1924x1556px: 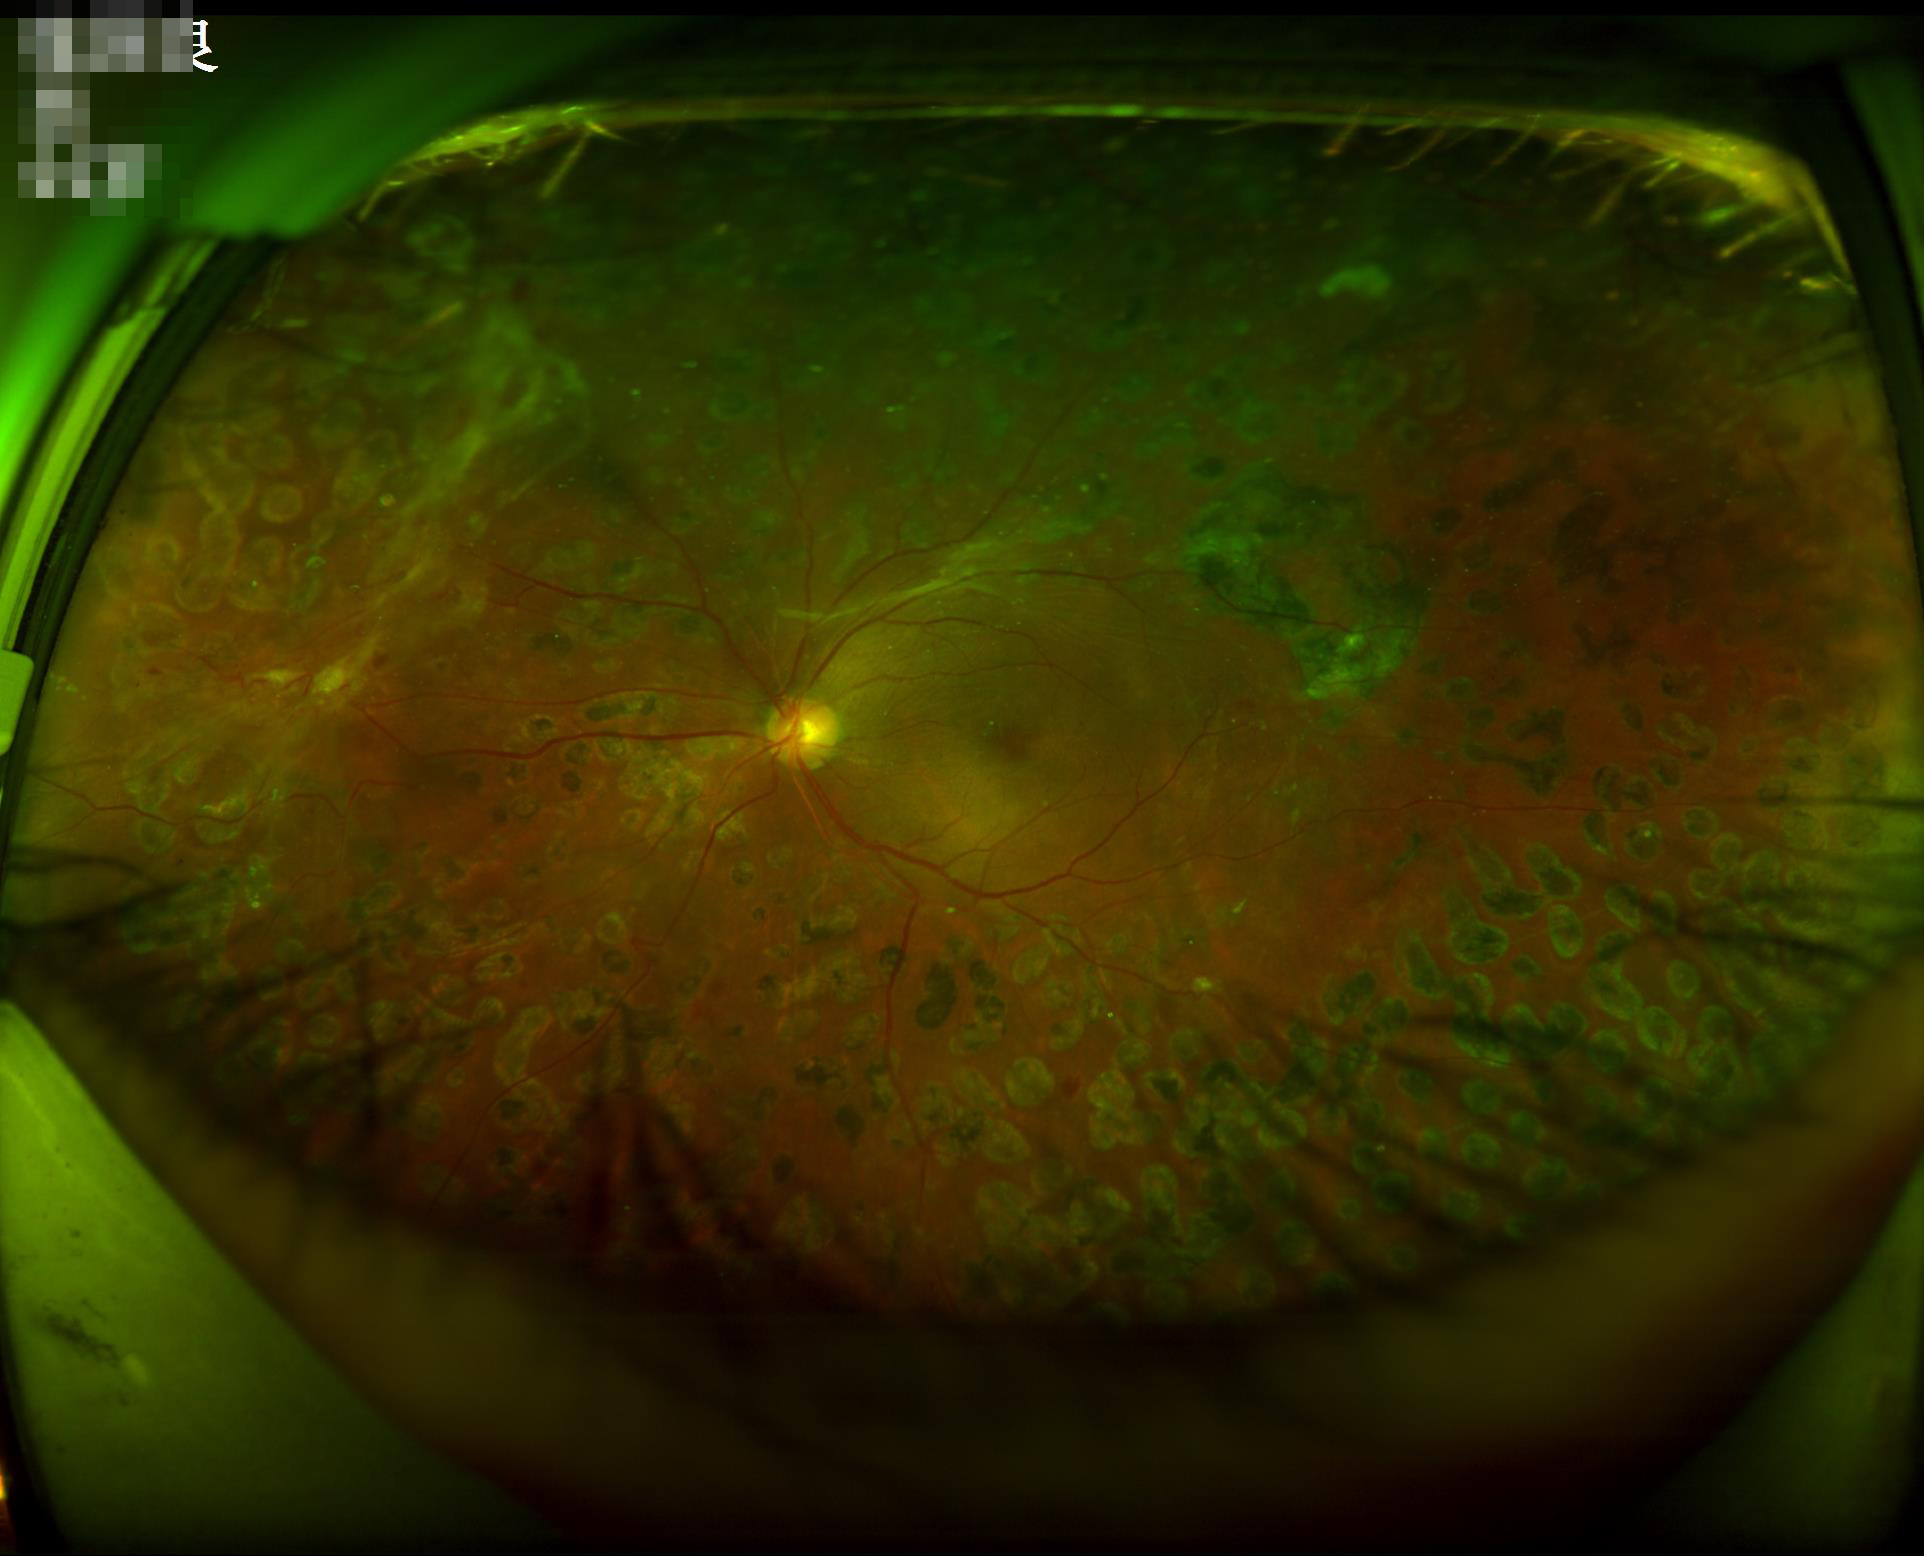 Even illumination with no color cast.
Overall image quality is good.
No noticeable blur.
Good dynamic range.